Infant wide-field retinal image · image size 1240x1240: 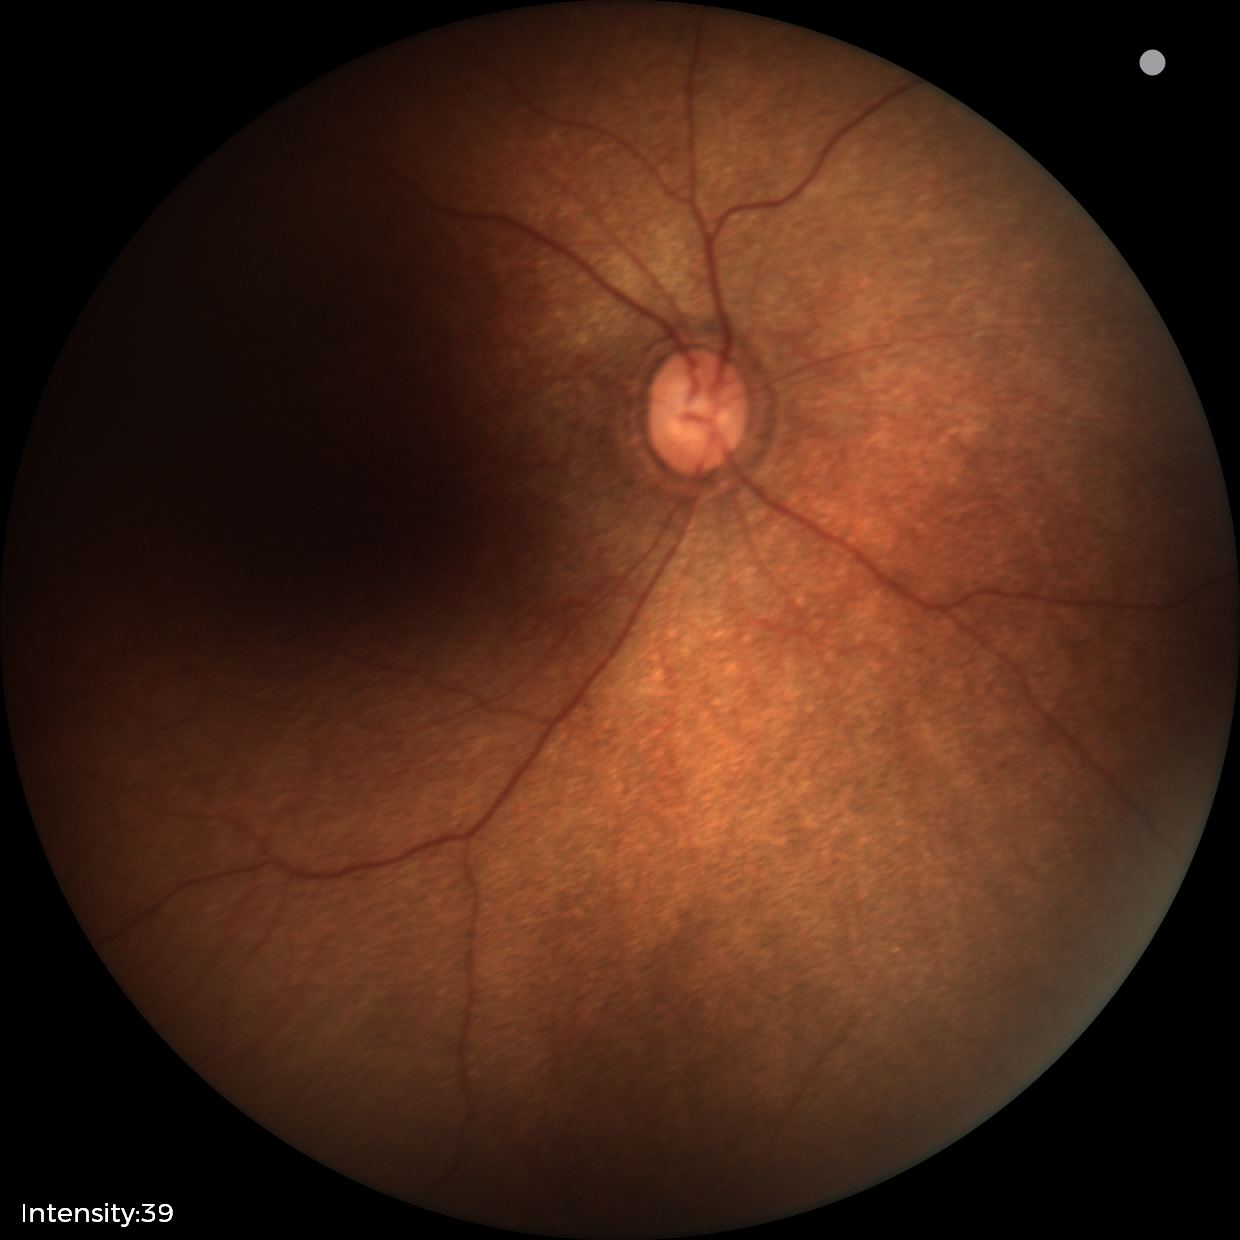
Screening examination with no abnormal retinal findings.